45° field of view, fundus photo, 2352x1568
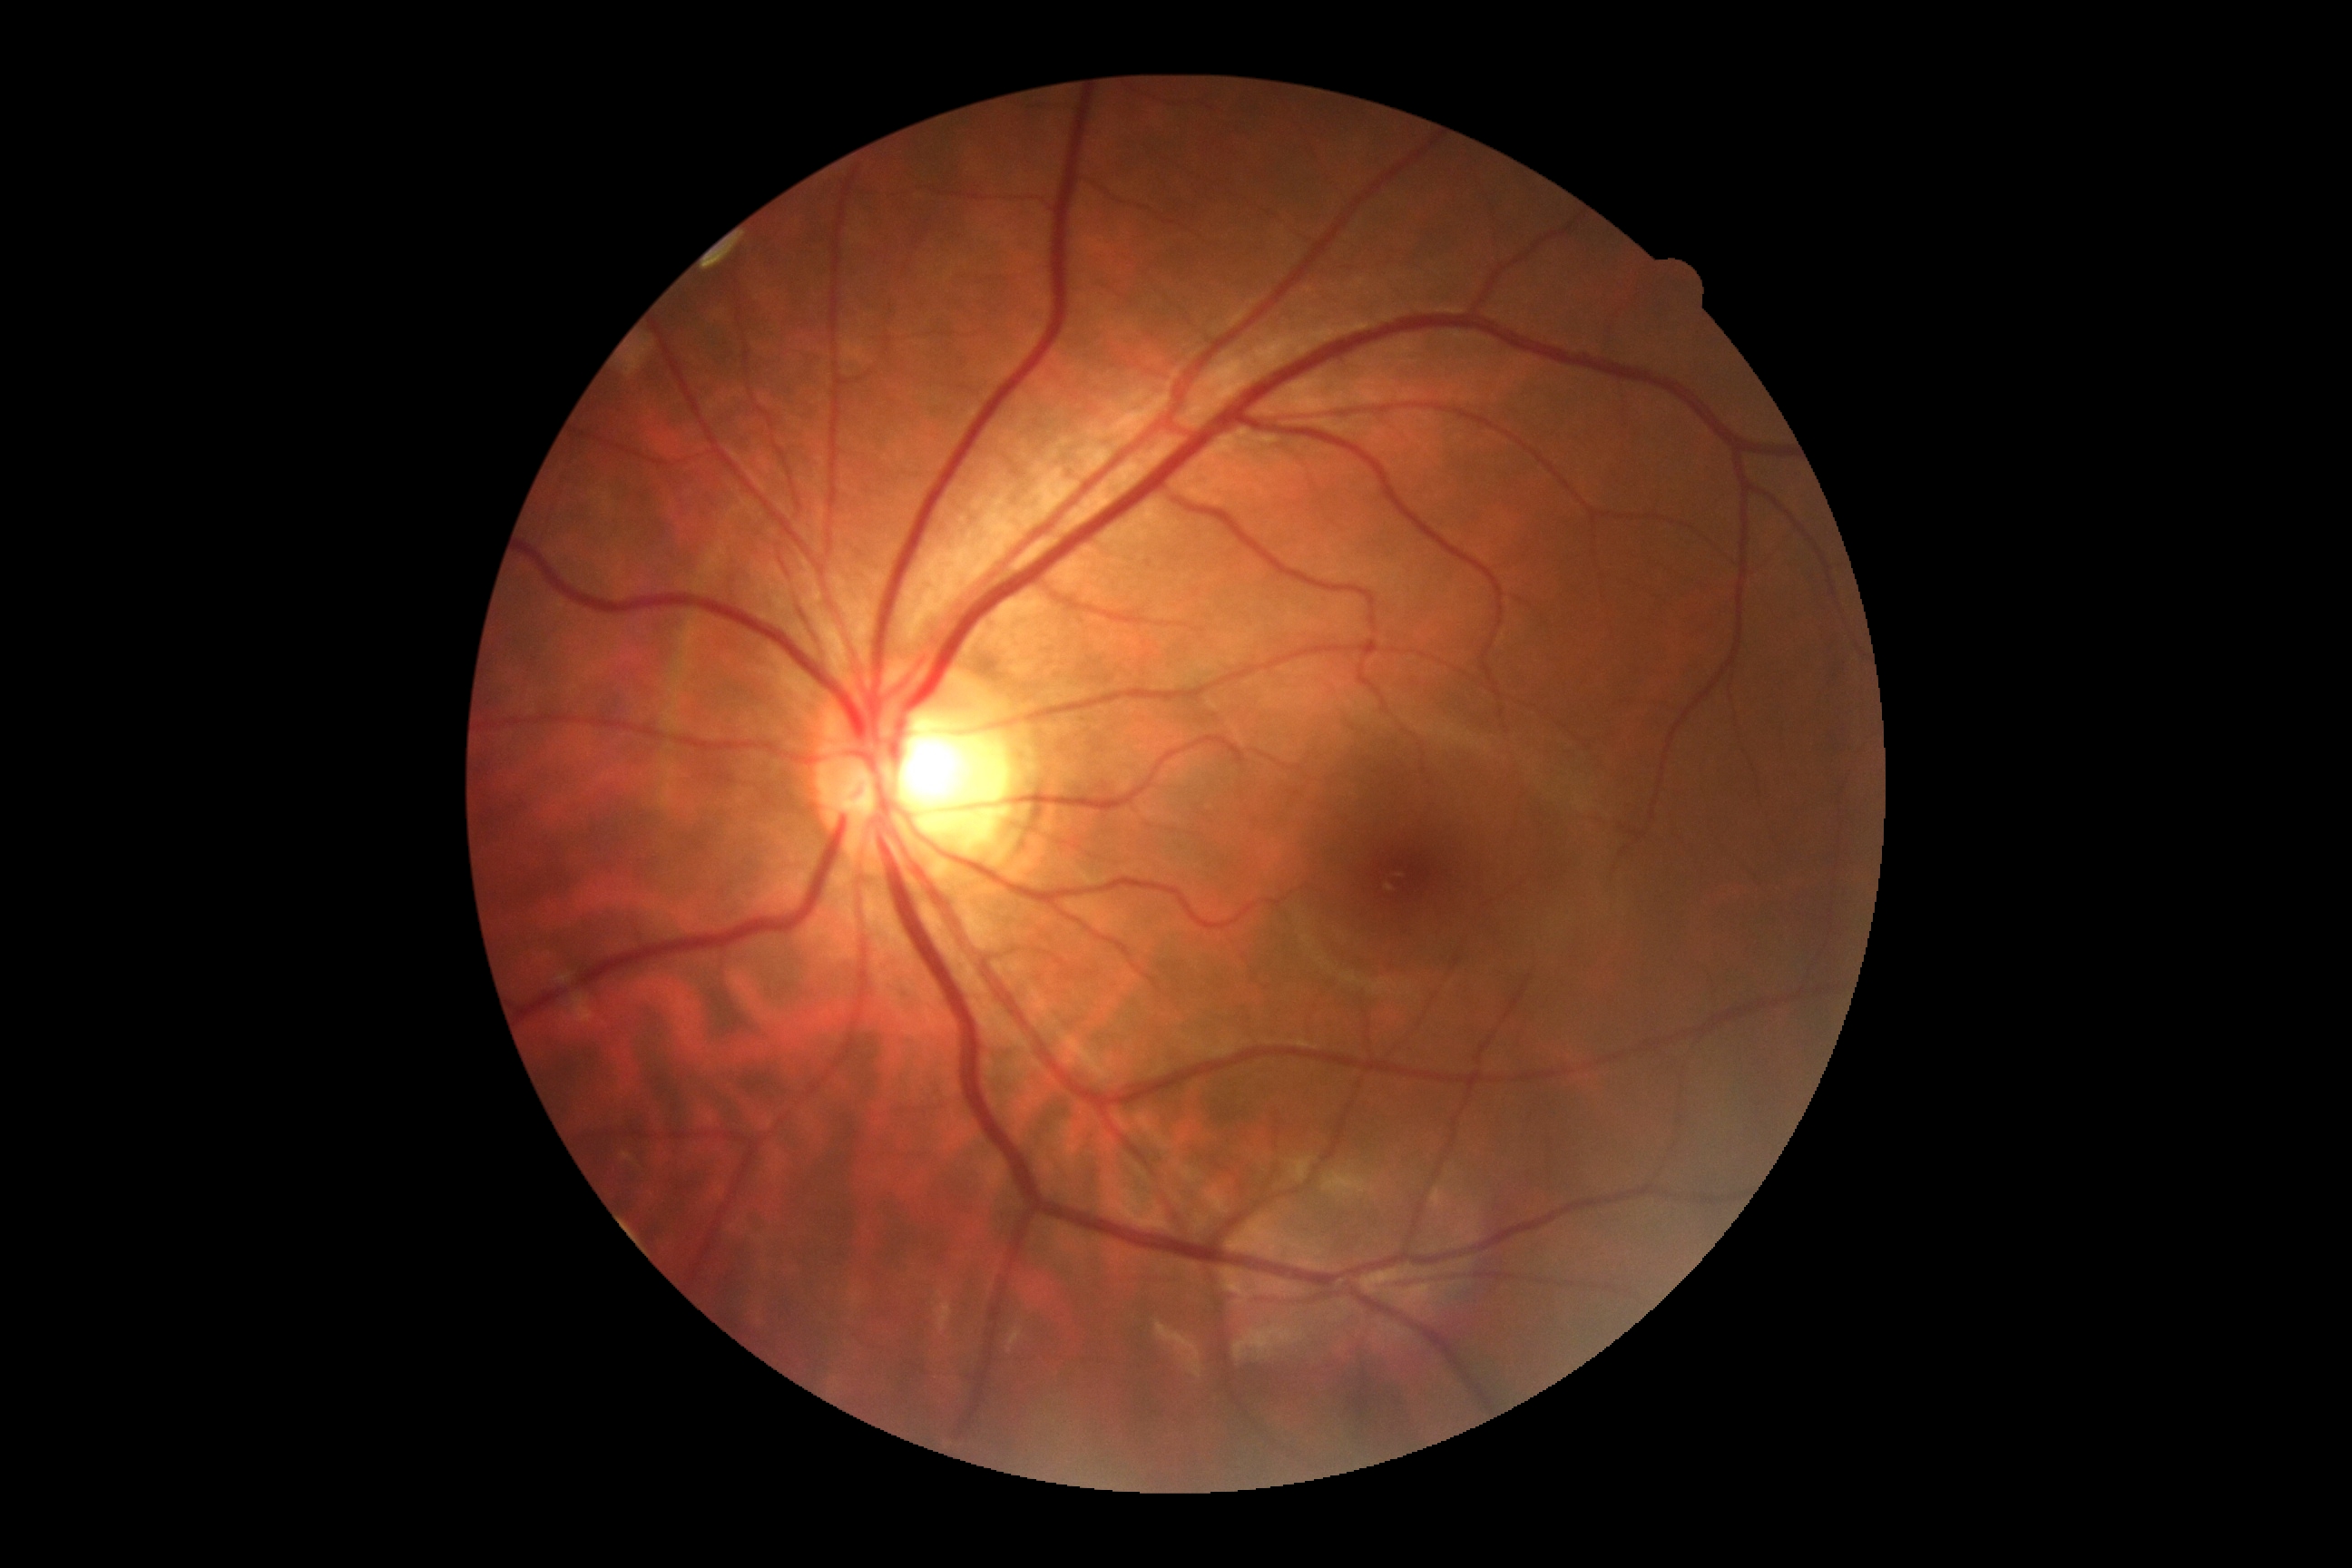

DR impression = no signs of DR, DR stage = grade 0.